Color fundus photograph.
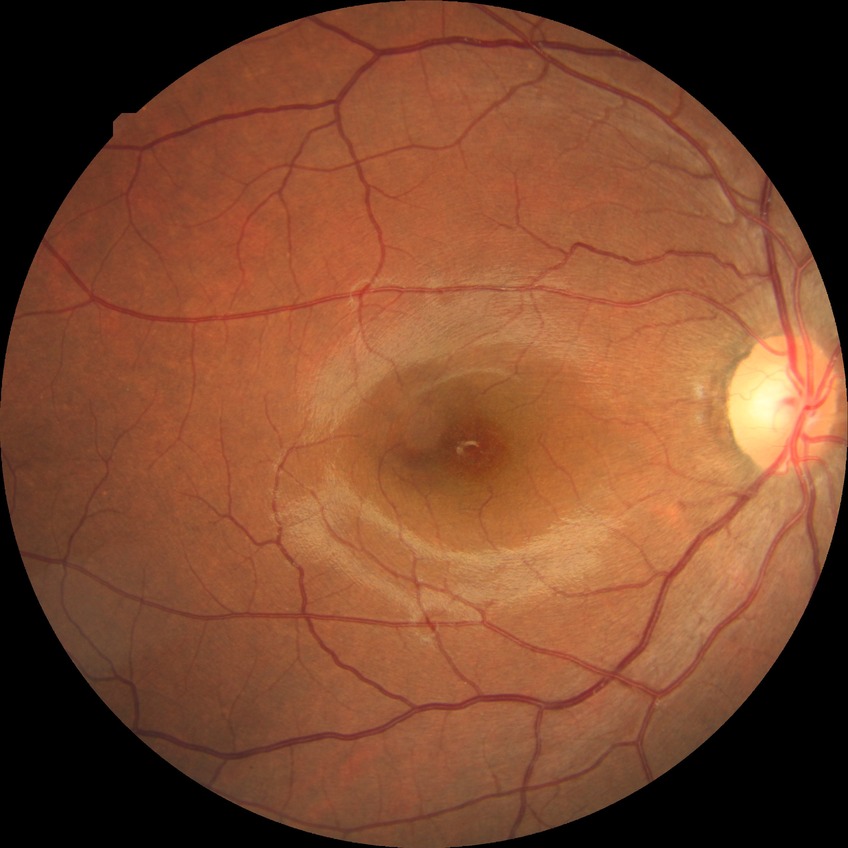 - DR impression: no apparent DR
- Davis grade: NDR